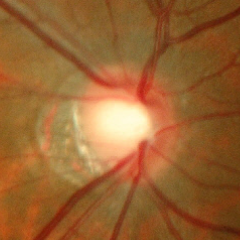 Diagnosis = early glaucomatous optic neuropathy.